Optic disc photograph; FOV 35° before cropping; captured on a Topcon TRC retinal camera — 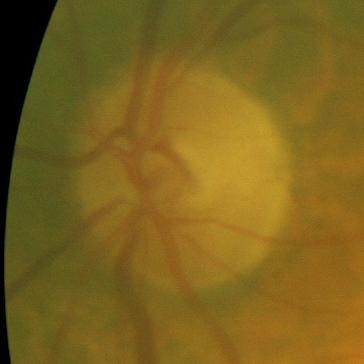
There is evidence of no glaucomatous changes.